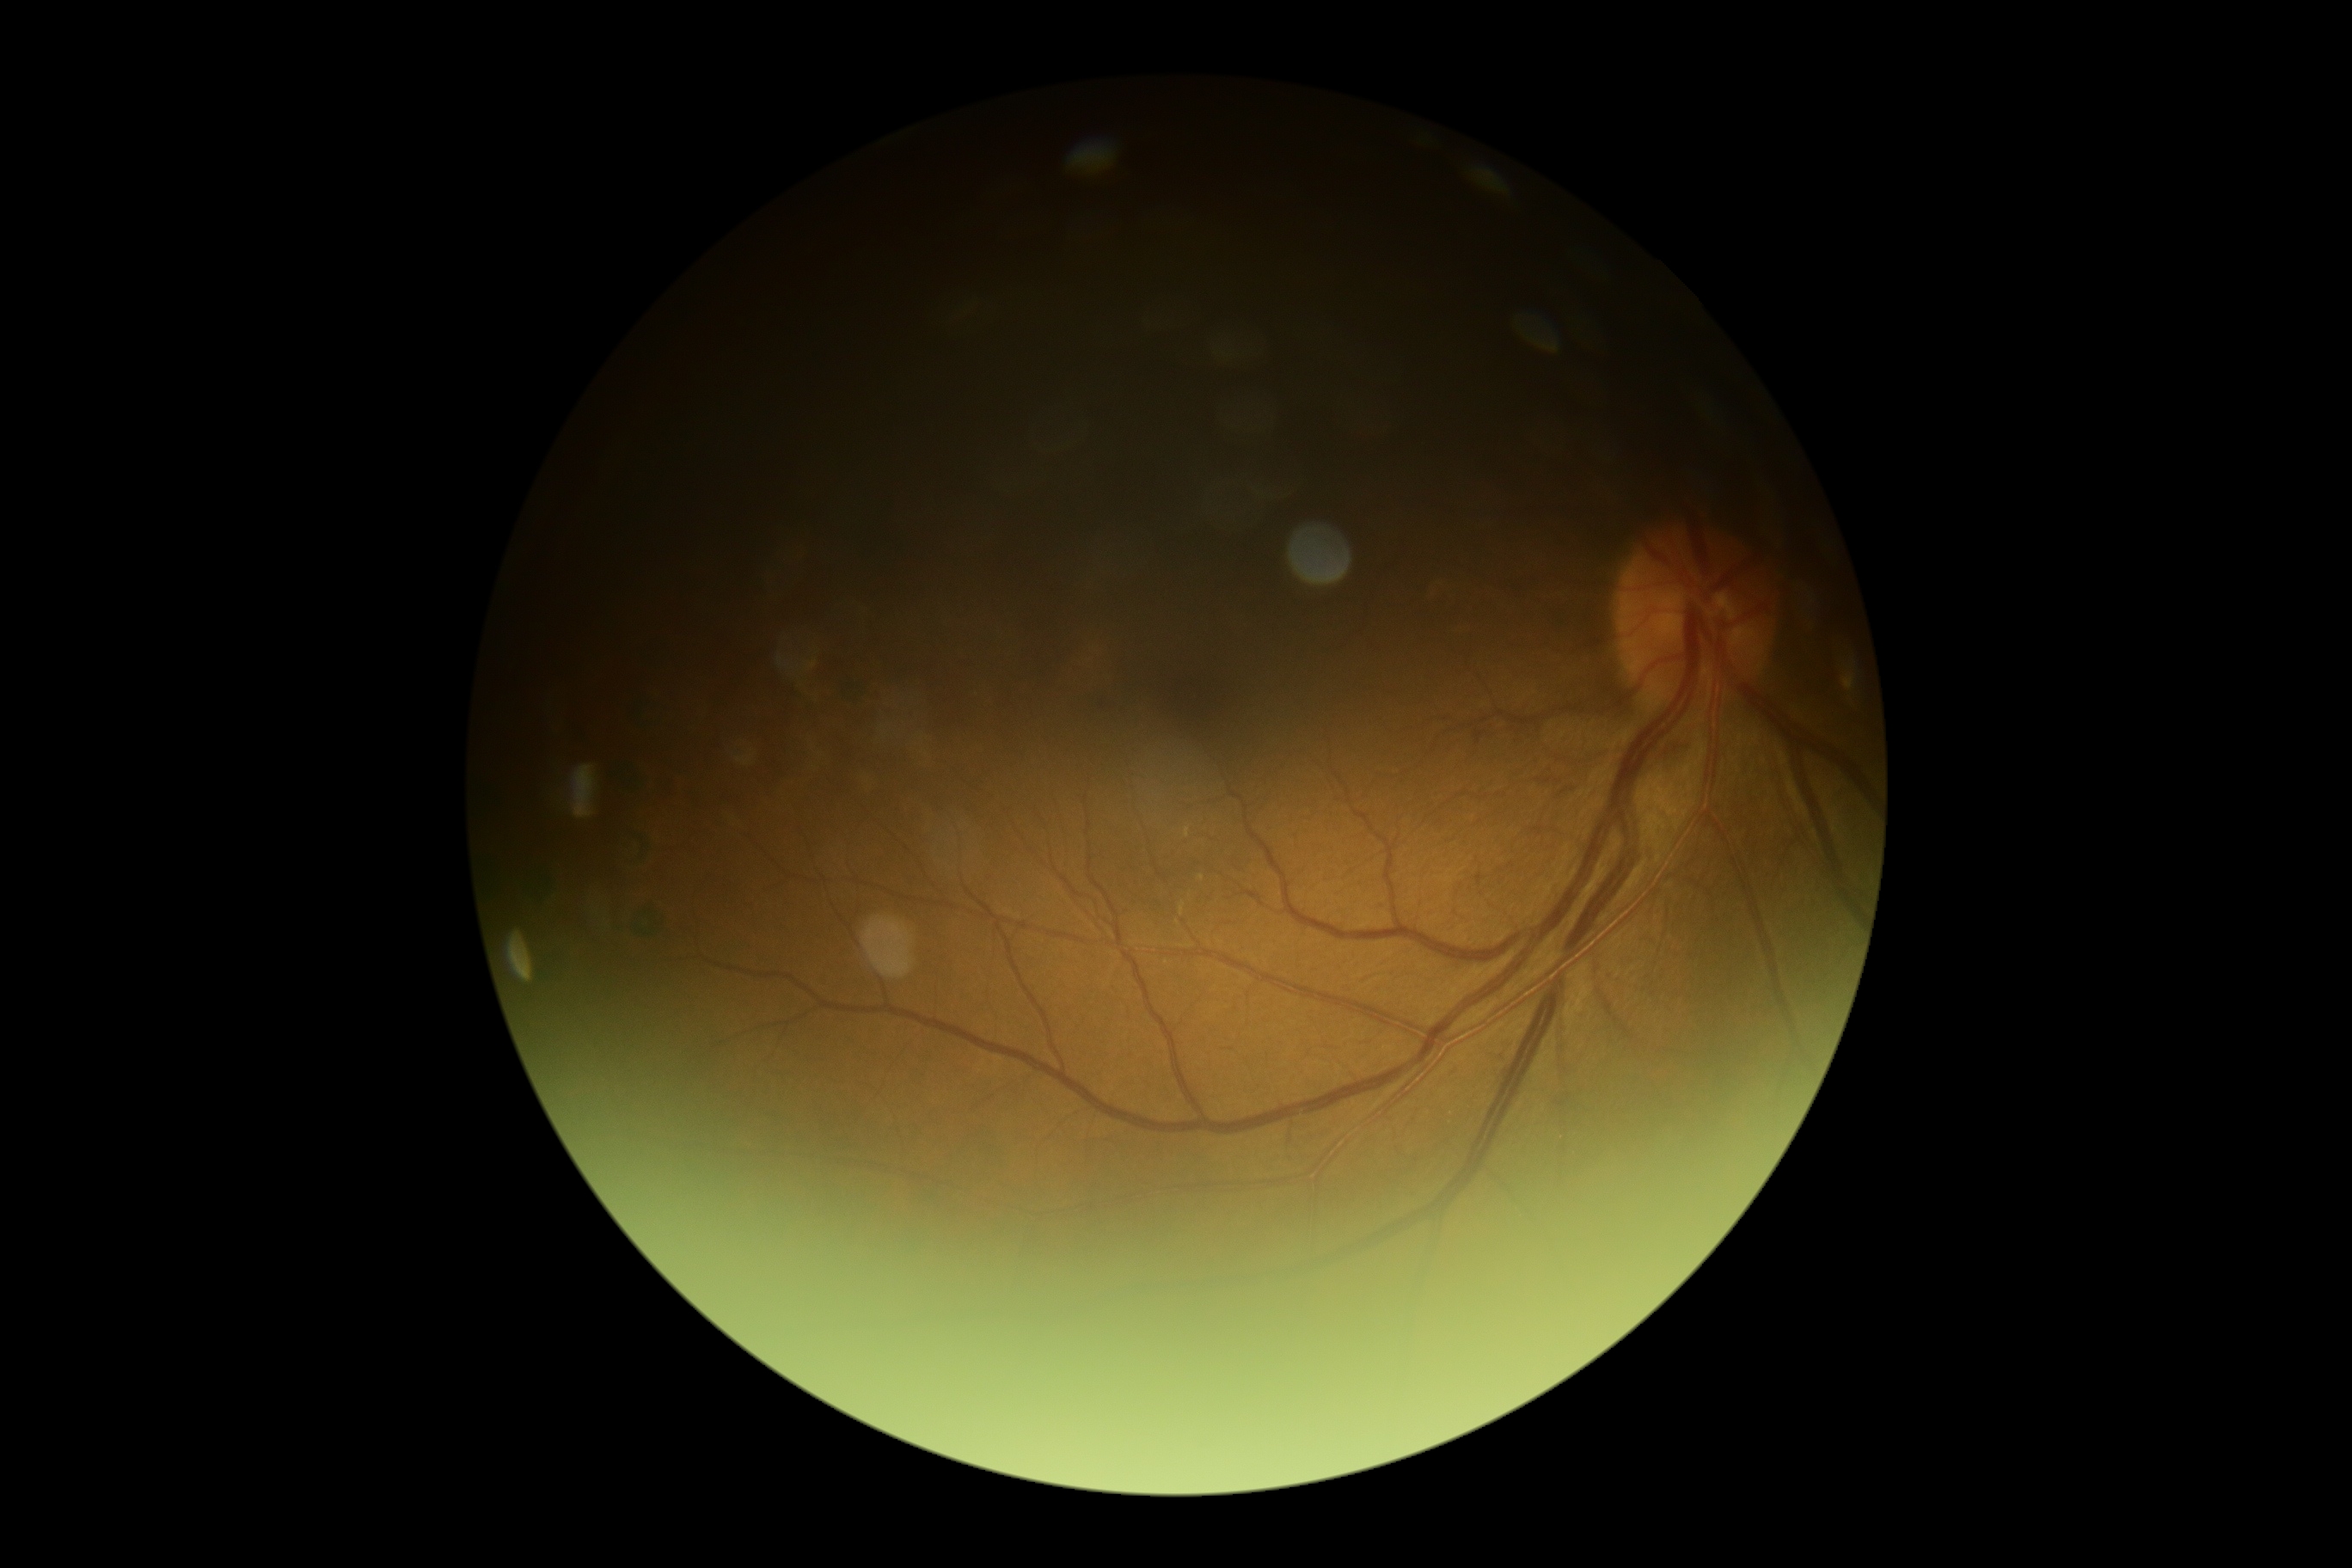

Retinopathy grade is 2 (moderate NPDR).